Captured without pupil dilation — 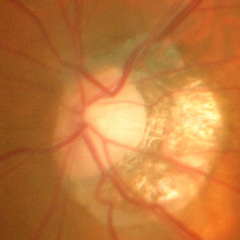

Q: Does this eye have glaucoma?
A: Advanced-stage glaucoma.